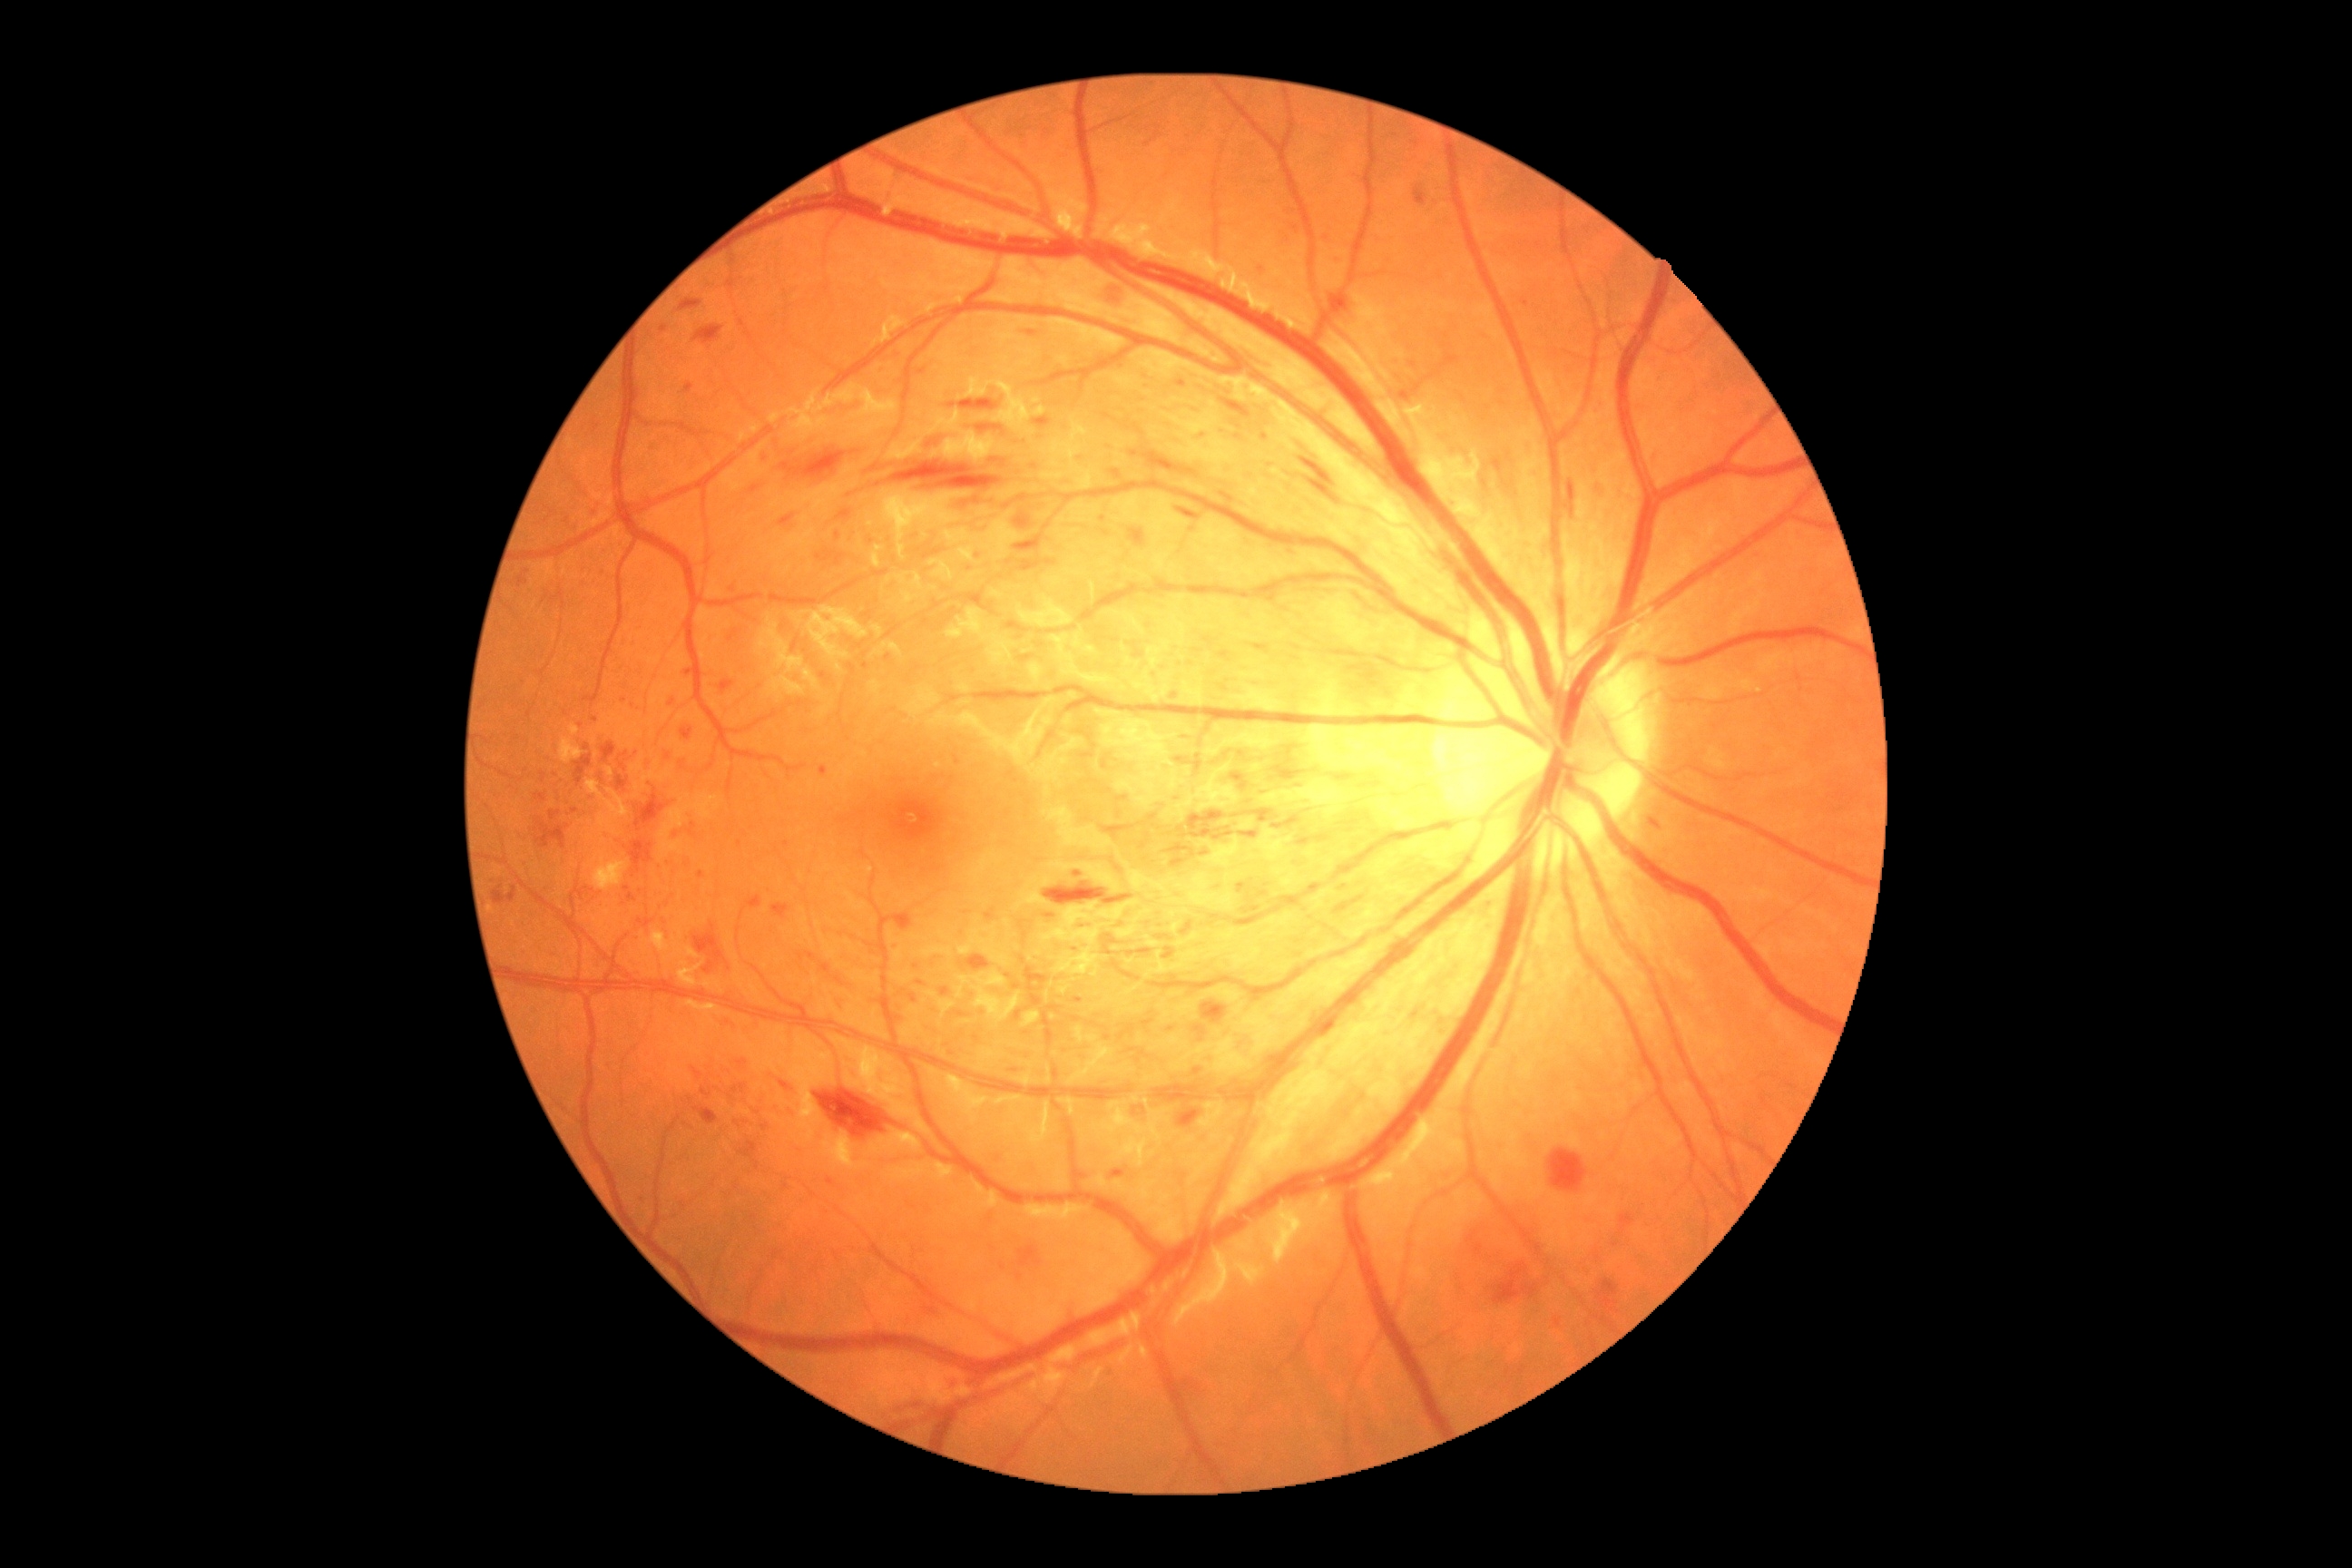
DR grade: 3/4.